FOV: 50 degrees
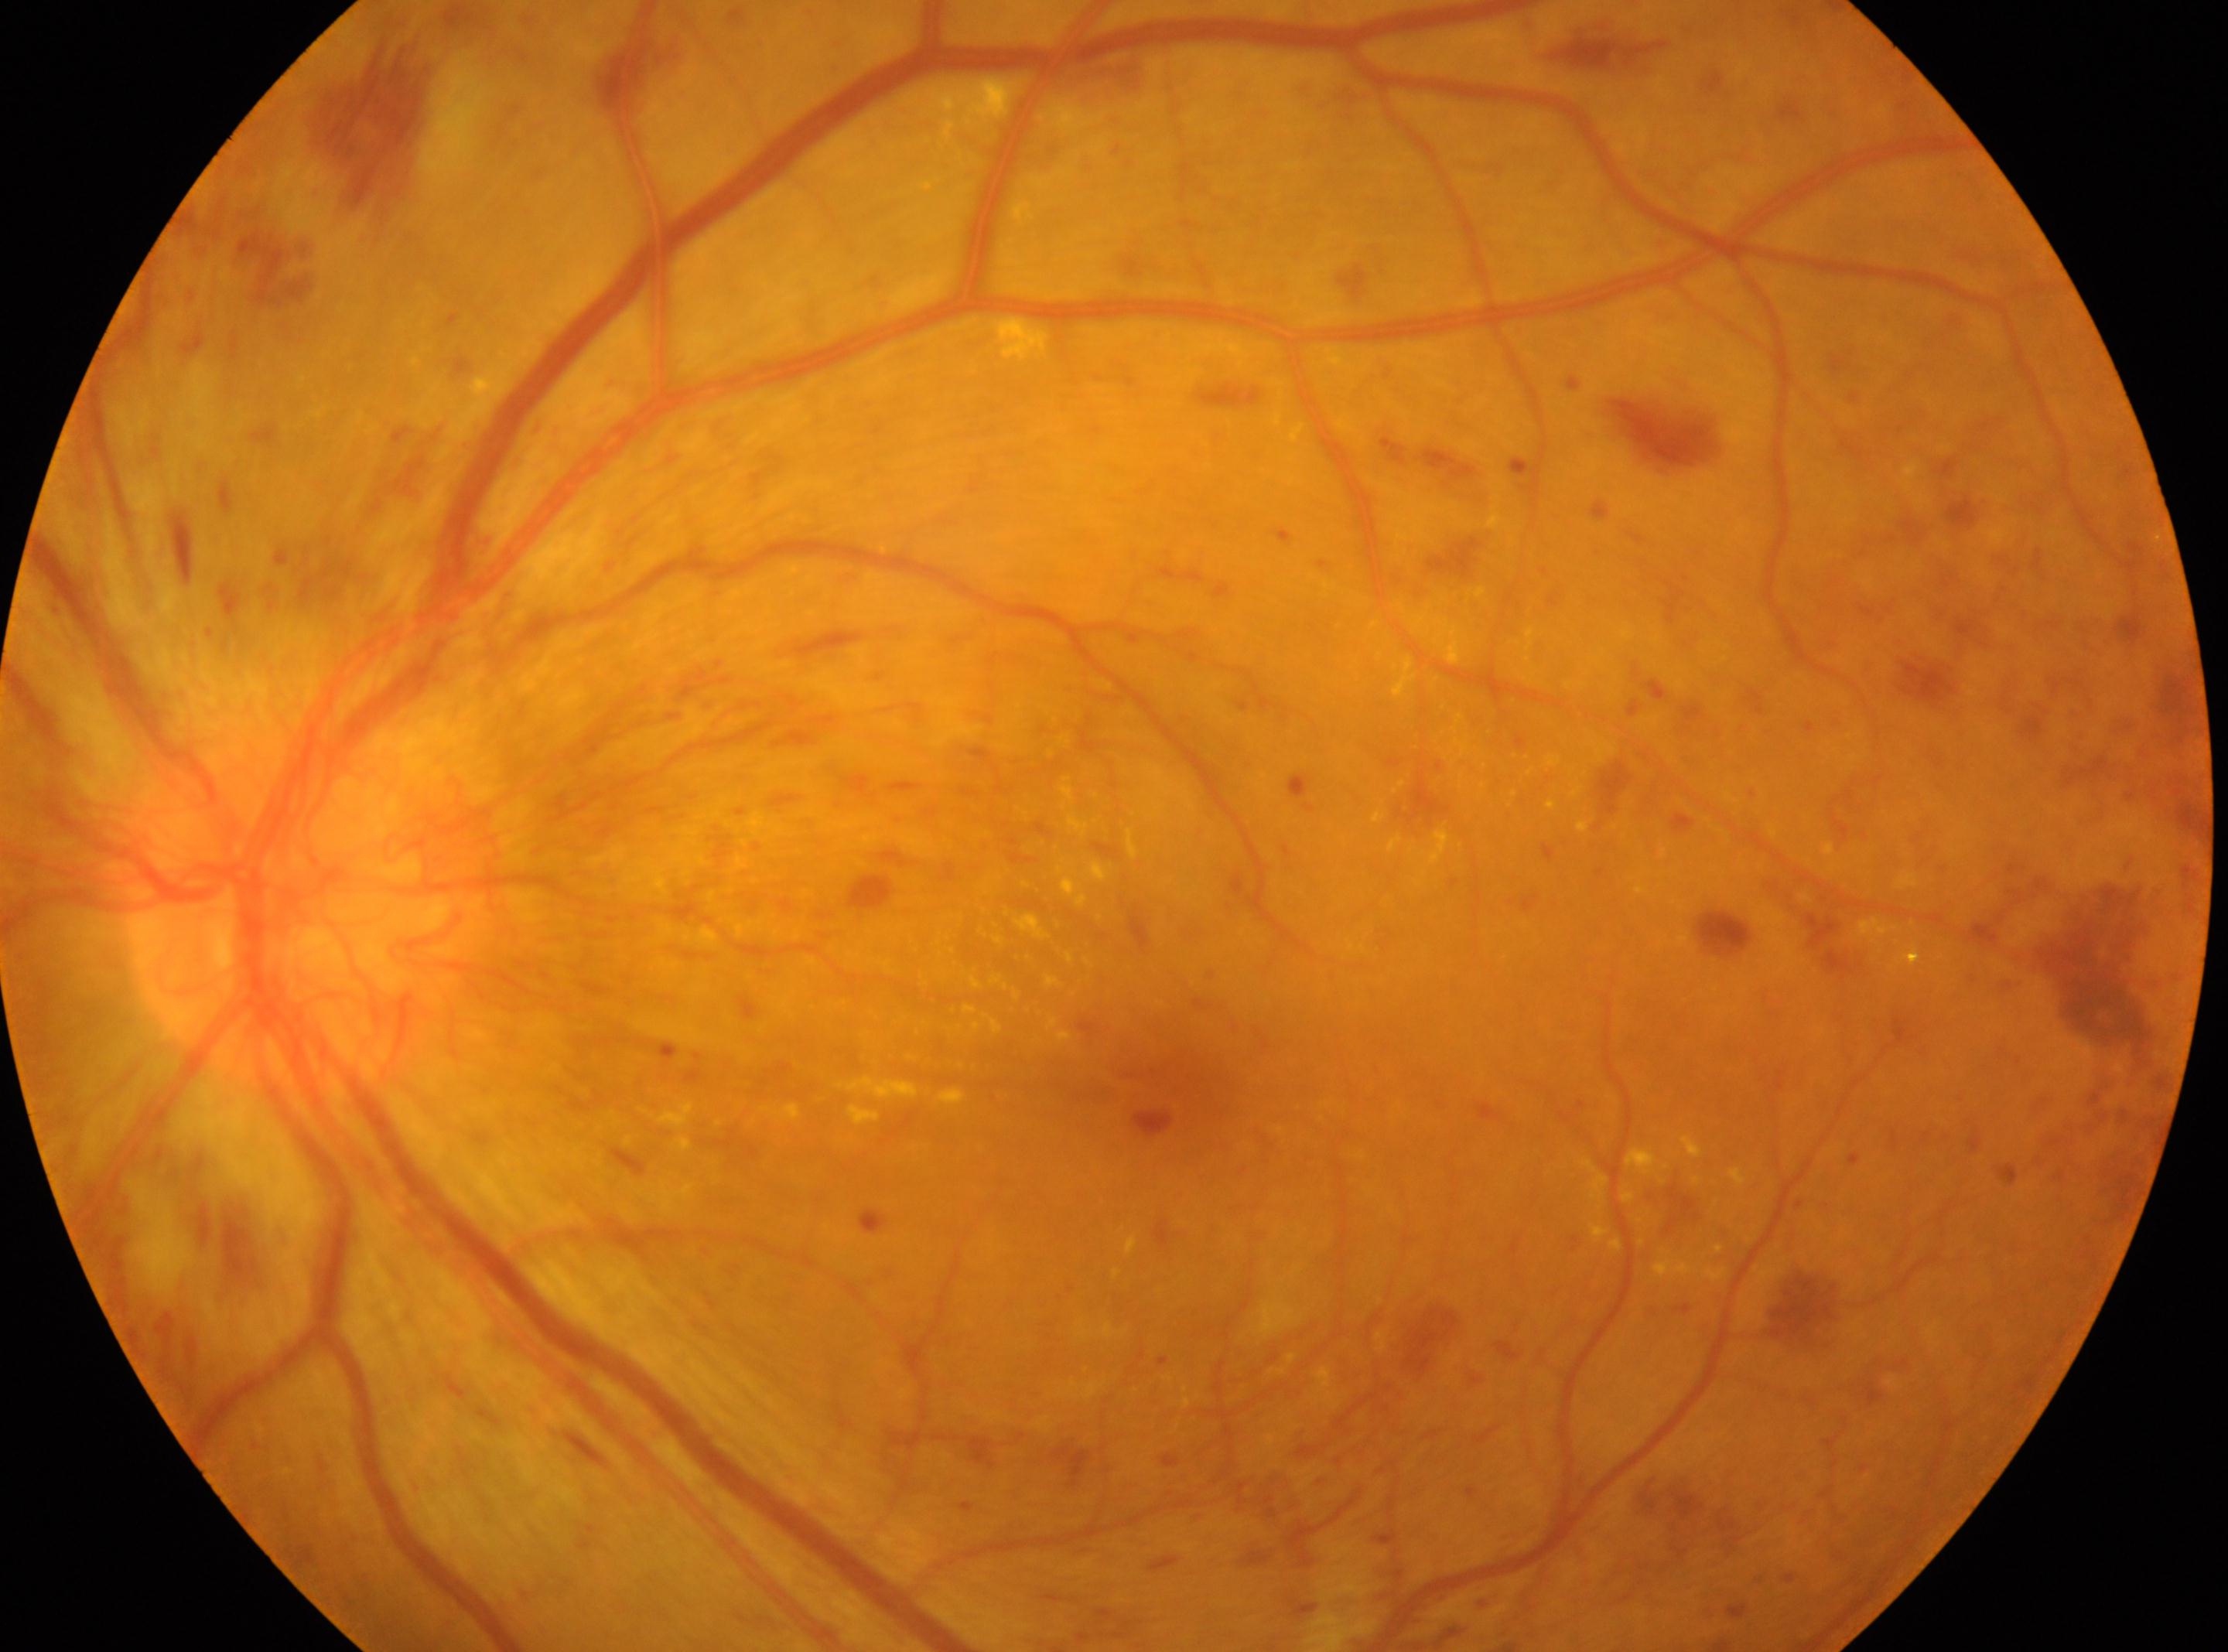
Fovea located at 1157, 1052. The retinopathy is classified as proliferative diabetic retinopathy. The image shows the left eye. DR grade is 4 (PDR). Optic disc: 296, 910.